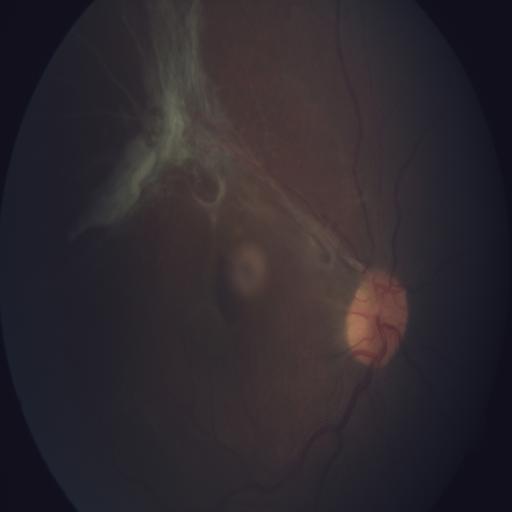

Diagnoses:
- preretinal hemorrhage
- retinal traction